Color fundus photograph — 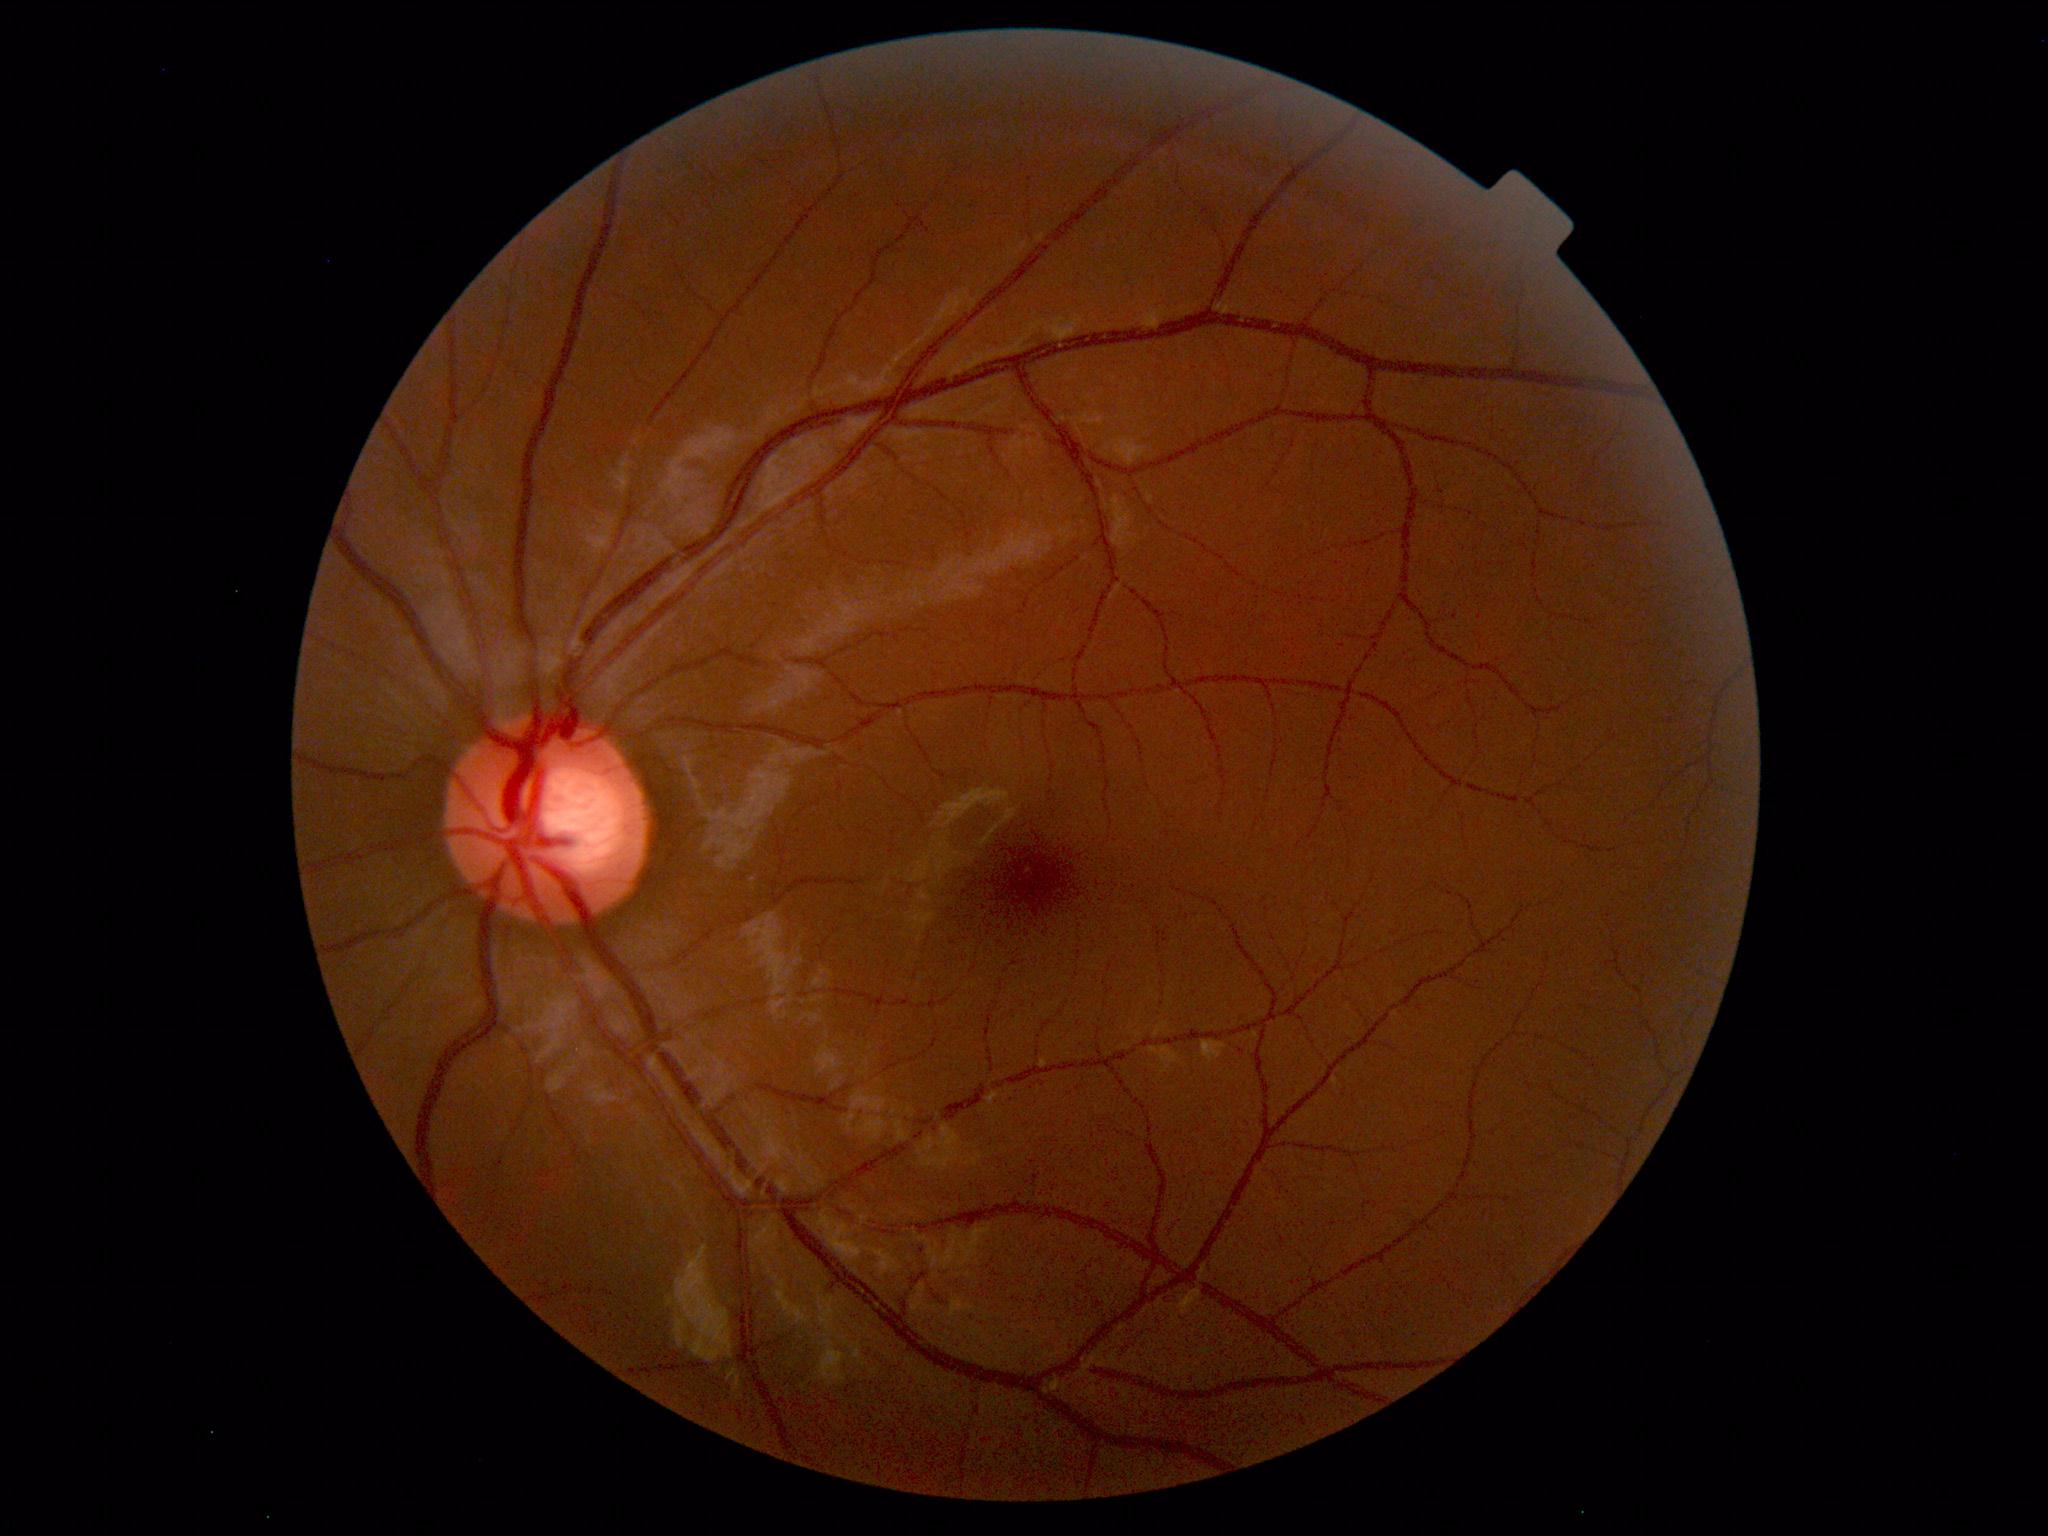
Findings: none. Normal fundus.